Modified Davis classification: 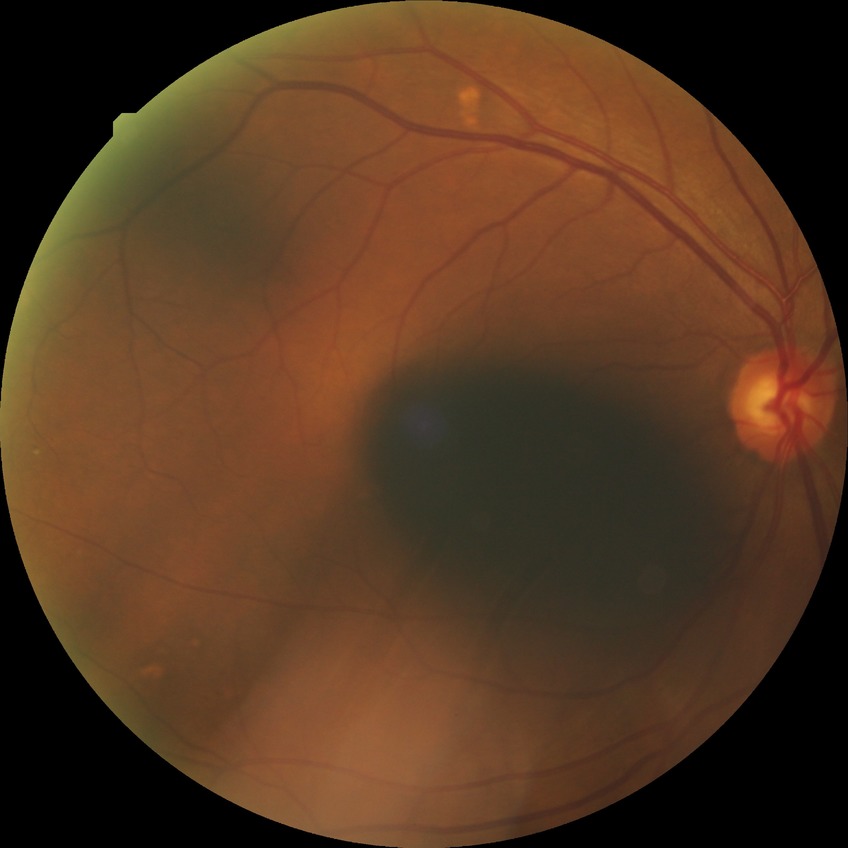 Modified Davis classification: simple diabetic retinopathy.